130° field of view (Clarity RetCam 3). 640x480. Wide-field fundus image from infant ROP screening: 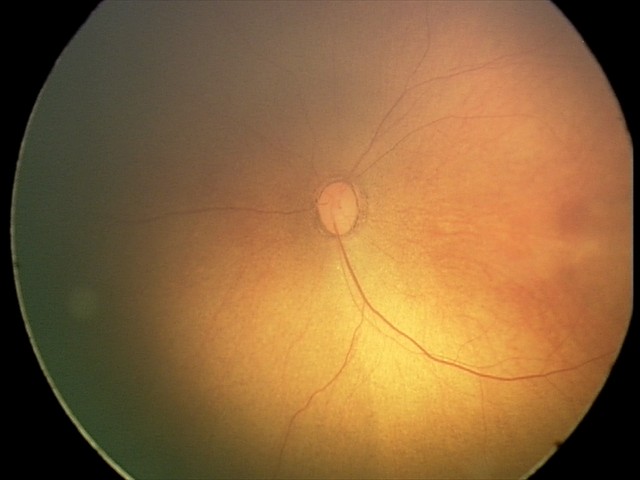
Examination with physiological retinal findings.